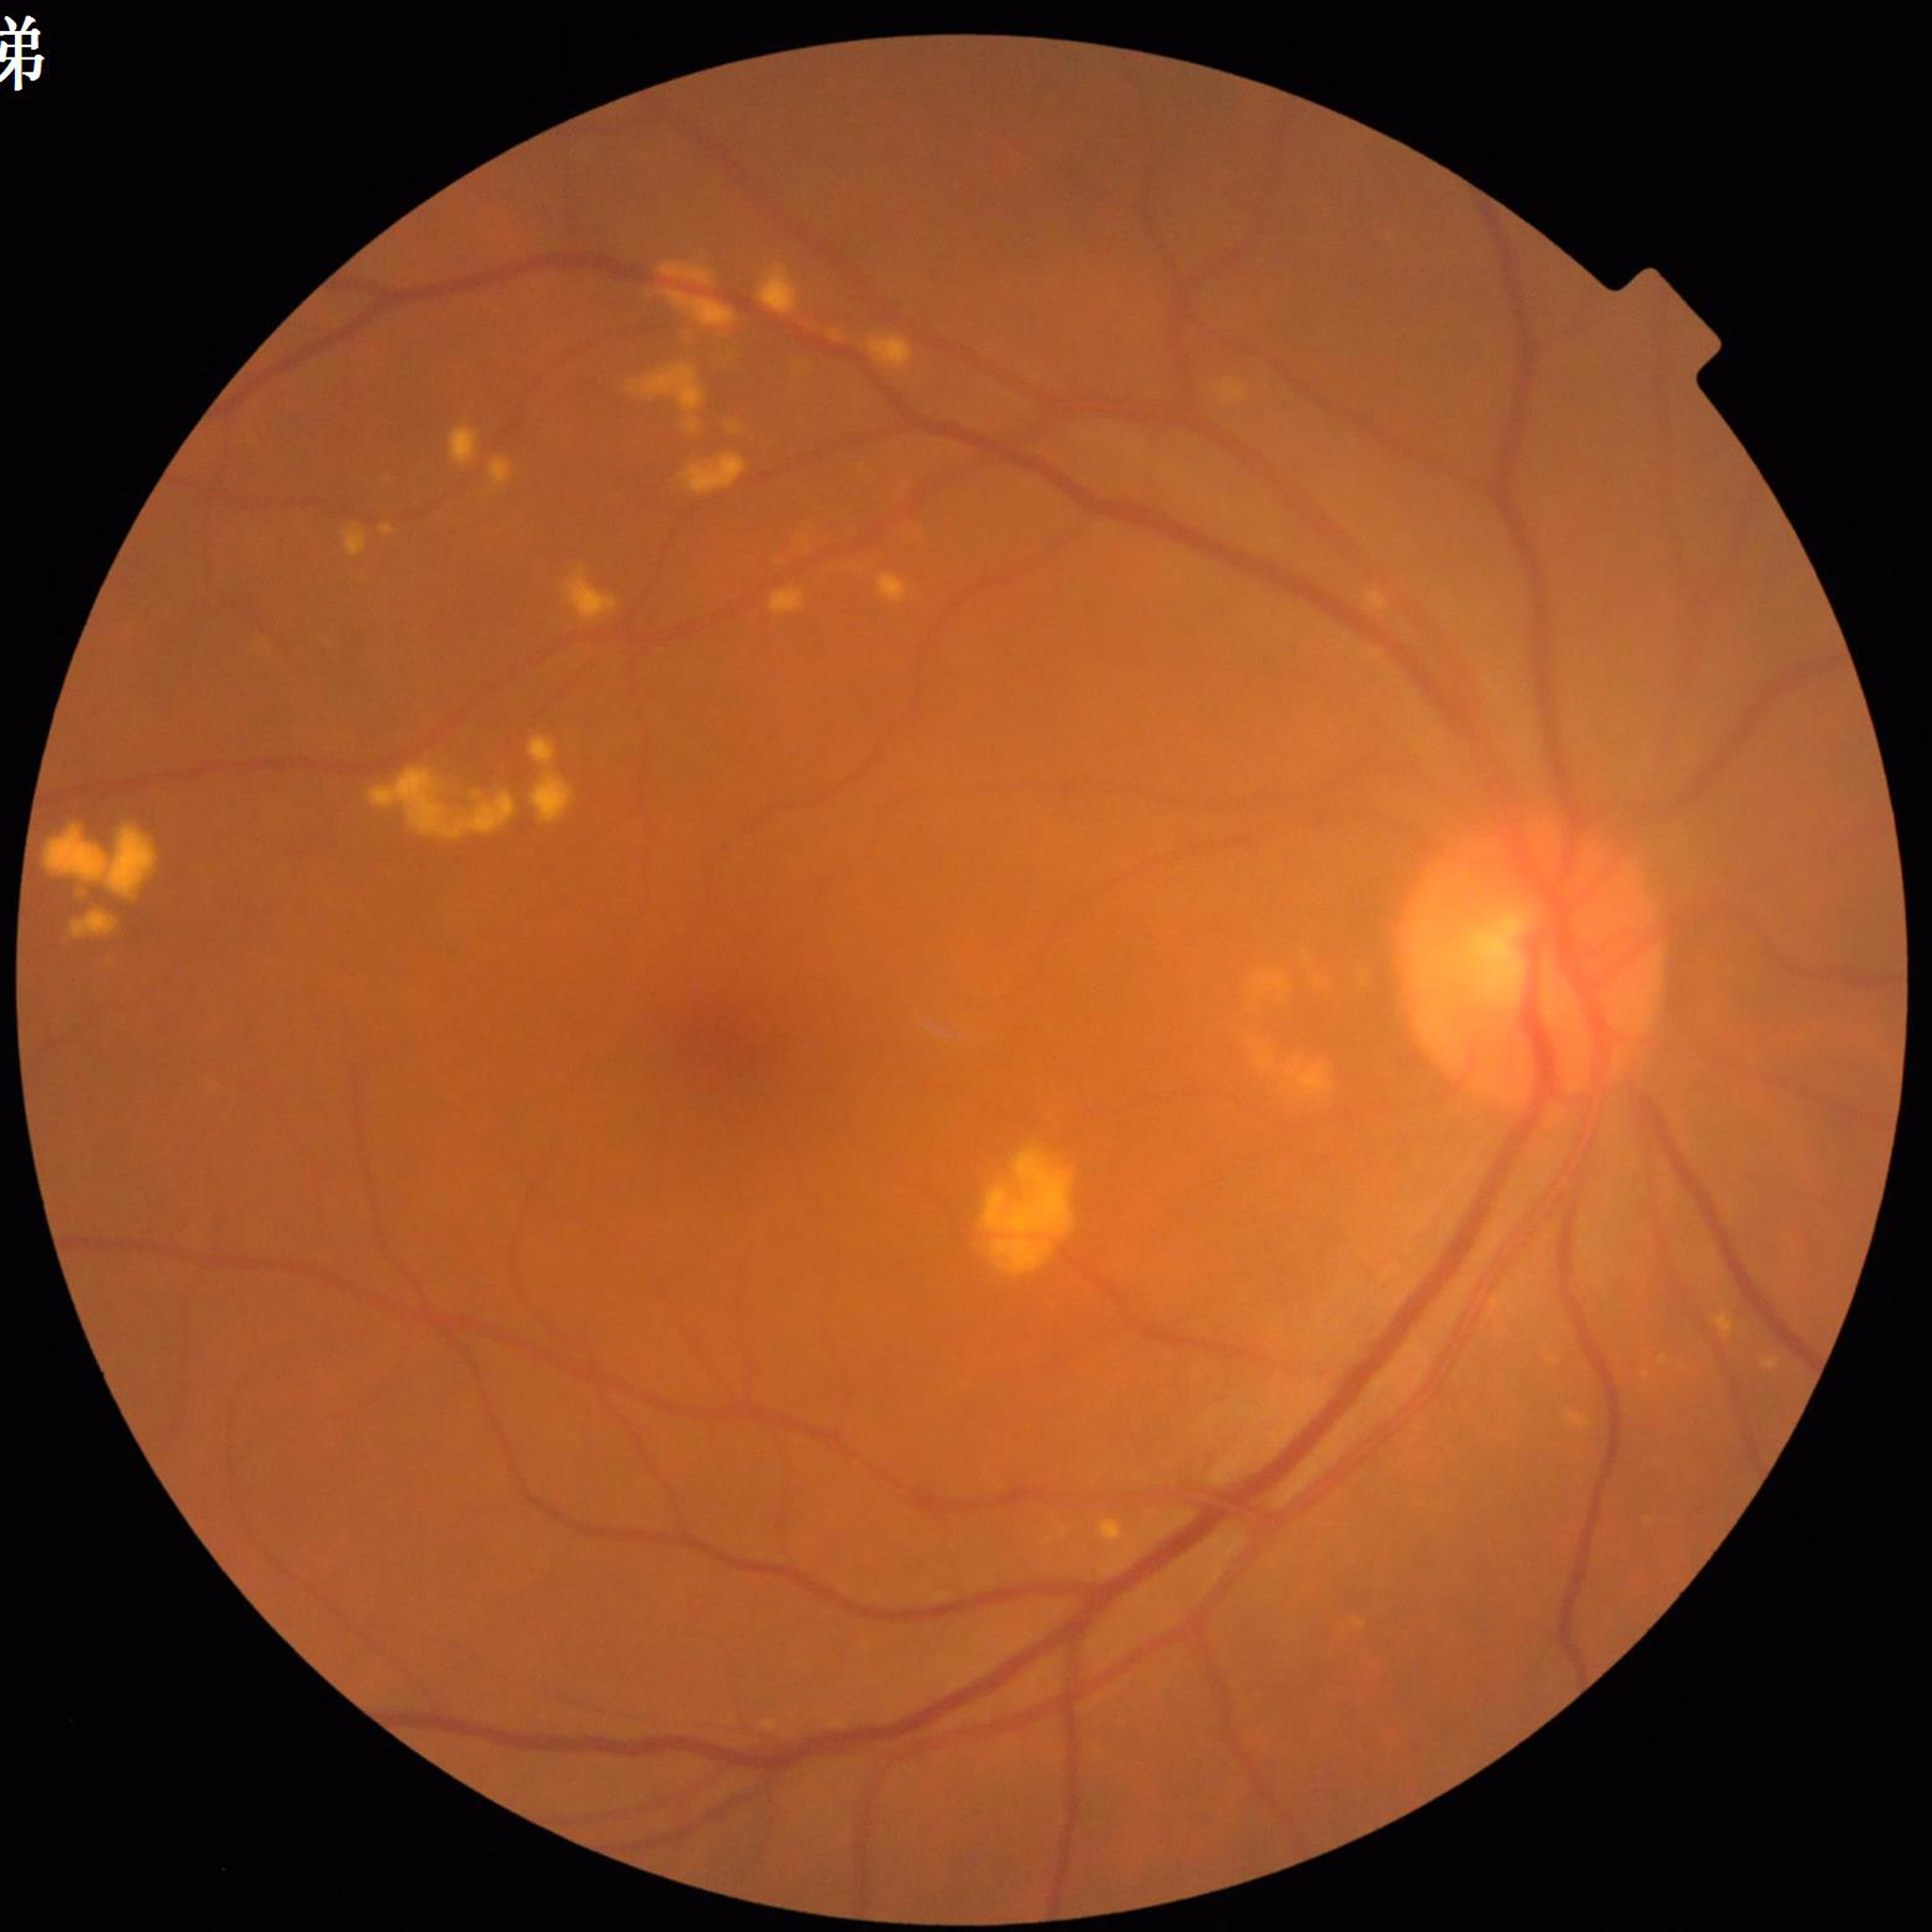

Quality: poor — blur | Diagnosis: age-related macular degeneration.